Pediatric wide-field fundus photograph. Clarity RetCam 3, 130° FOV
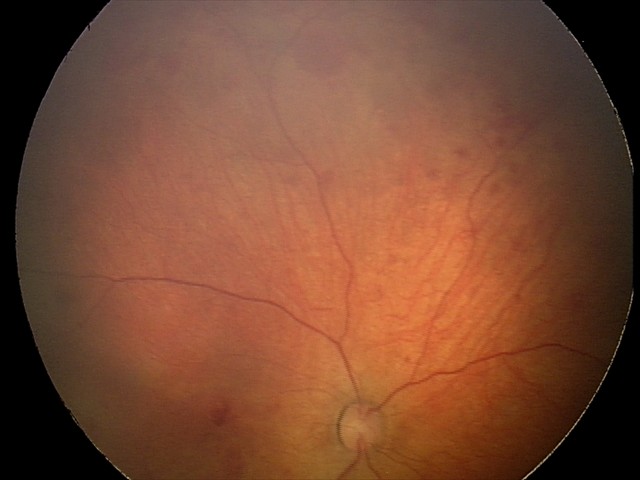 Examination diagnosed as retinal hemorrhages.